Pediatric retinal photograph (wide-field).
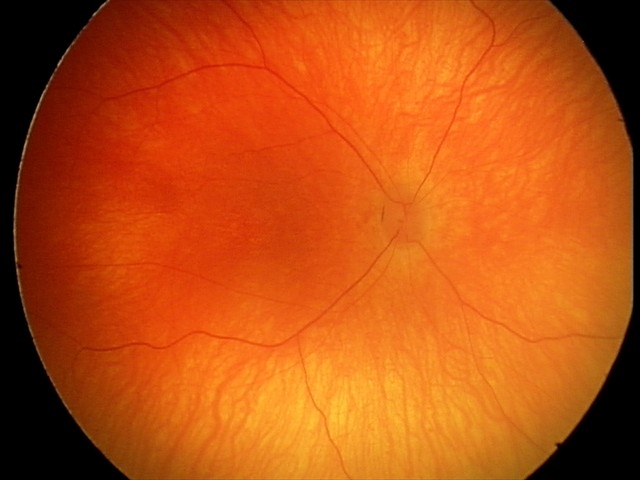 Screening examination with no abnormal retinal findings.